Wide-field fundus photograph from neonatal ROP screening. 640 by 480 pixels
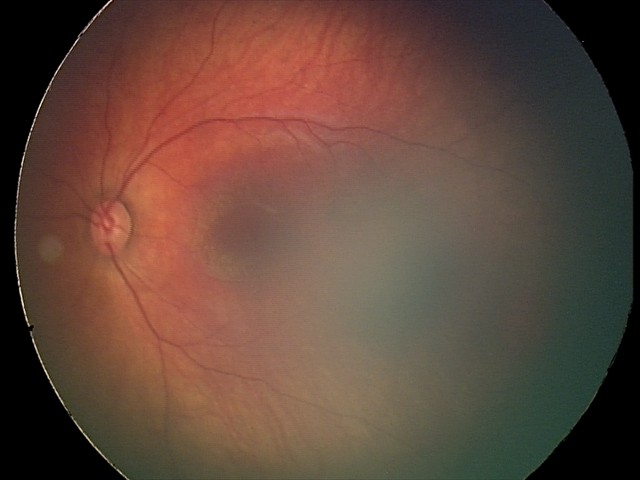
Screening series with retinal hemorrhages.